Wide-field fundus image from infant ROP screening — 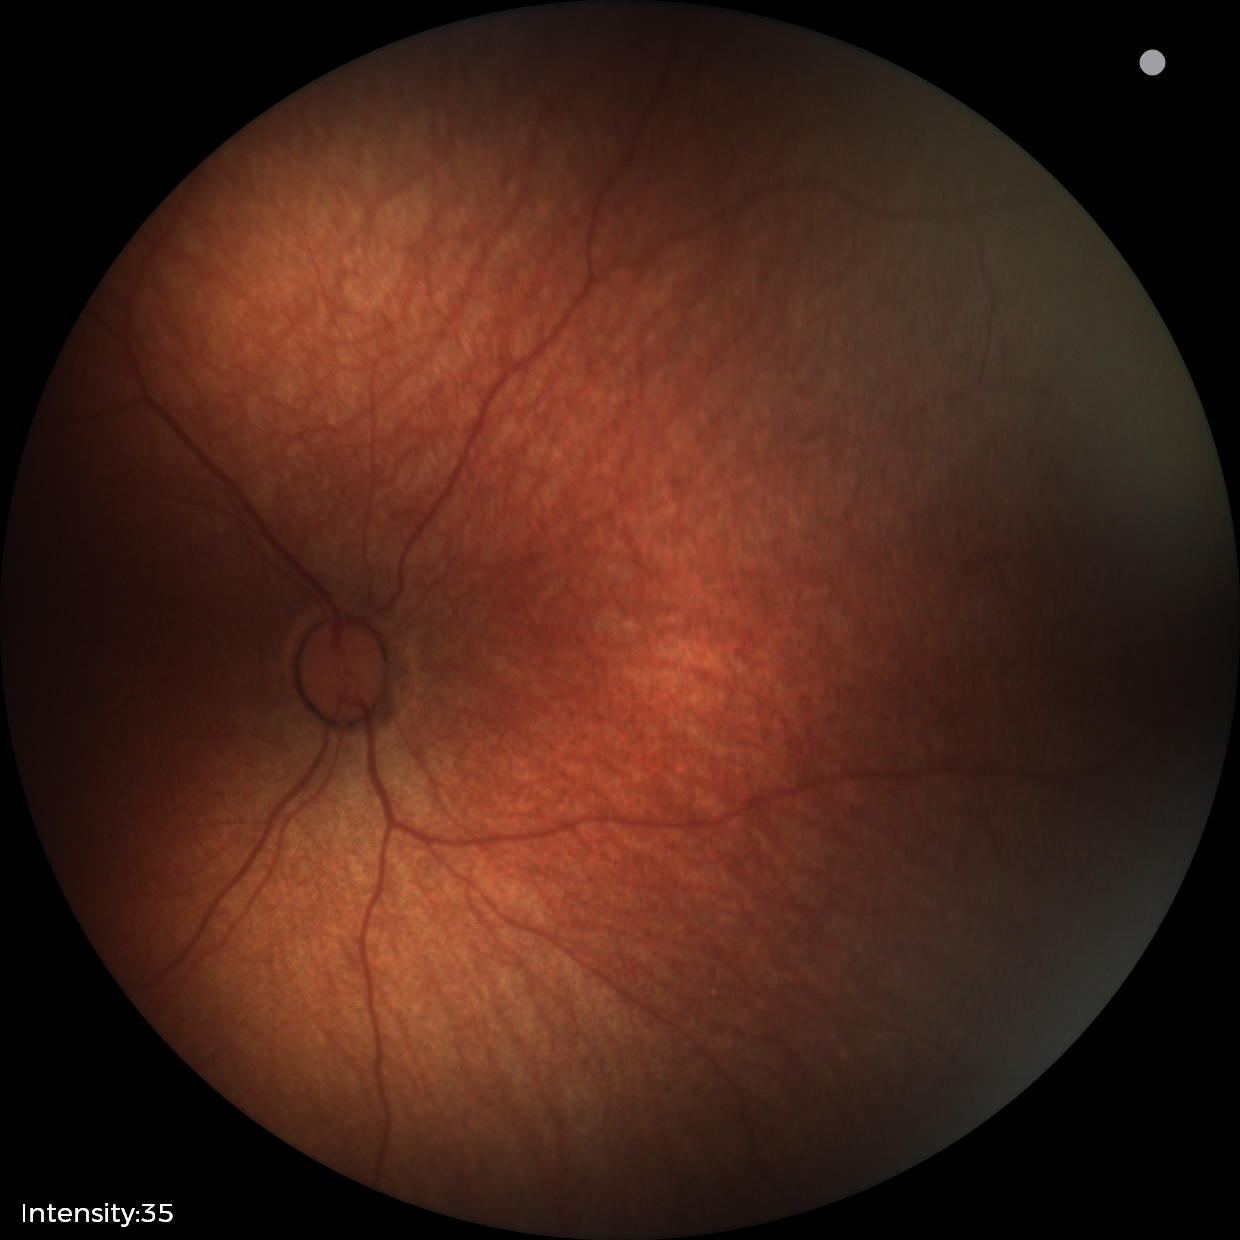
Physiological retinal appearance for postconceptual age.